CFP. 2352 by 1568 pixels — 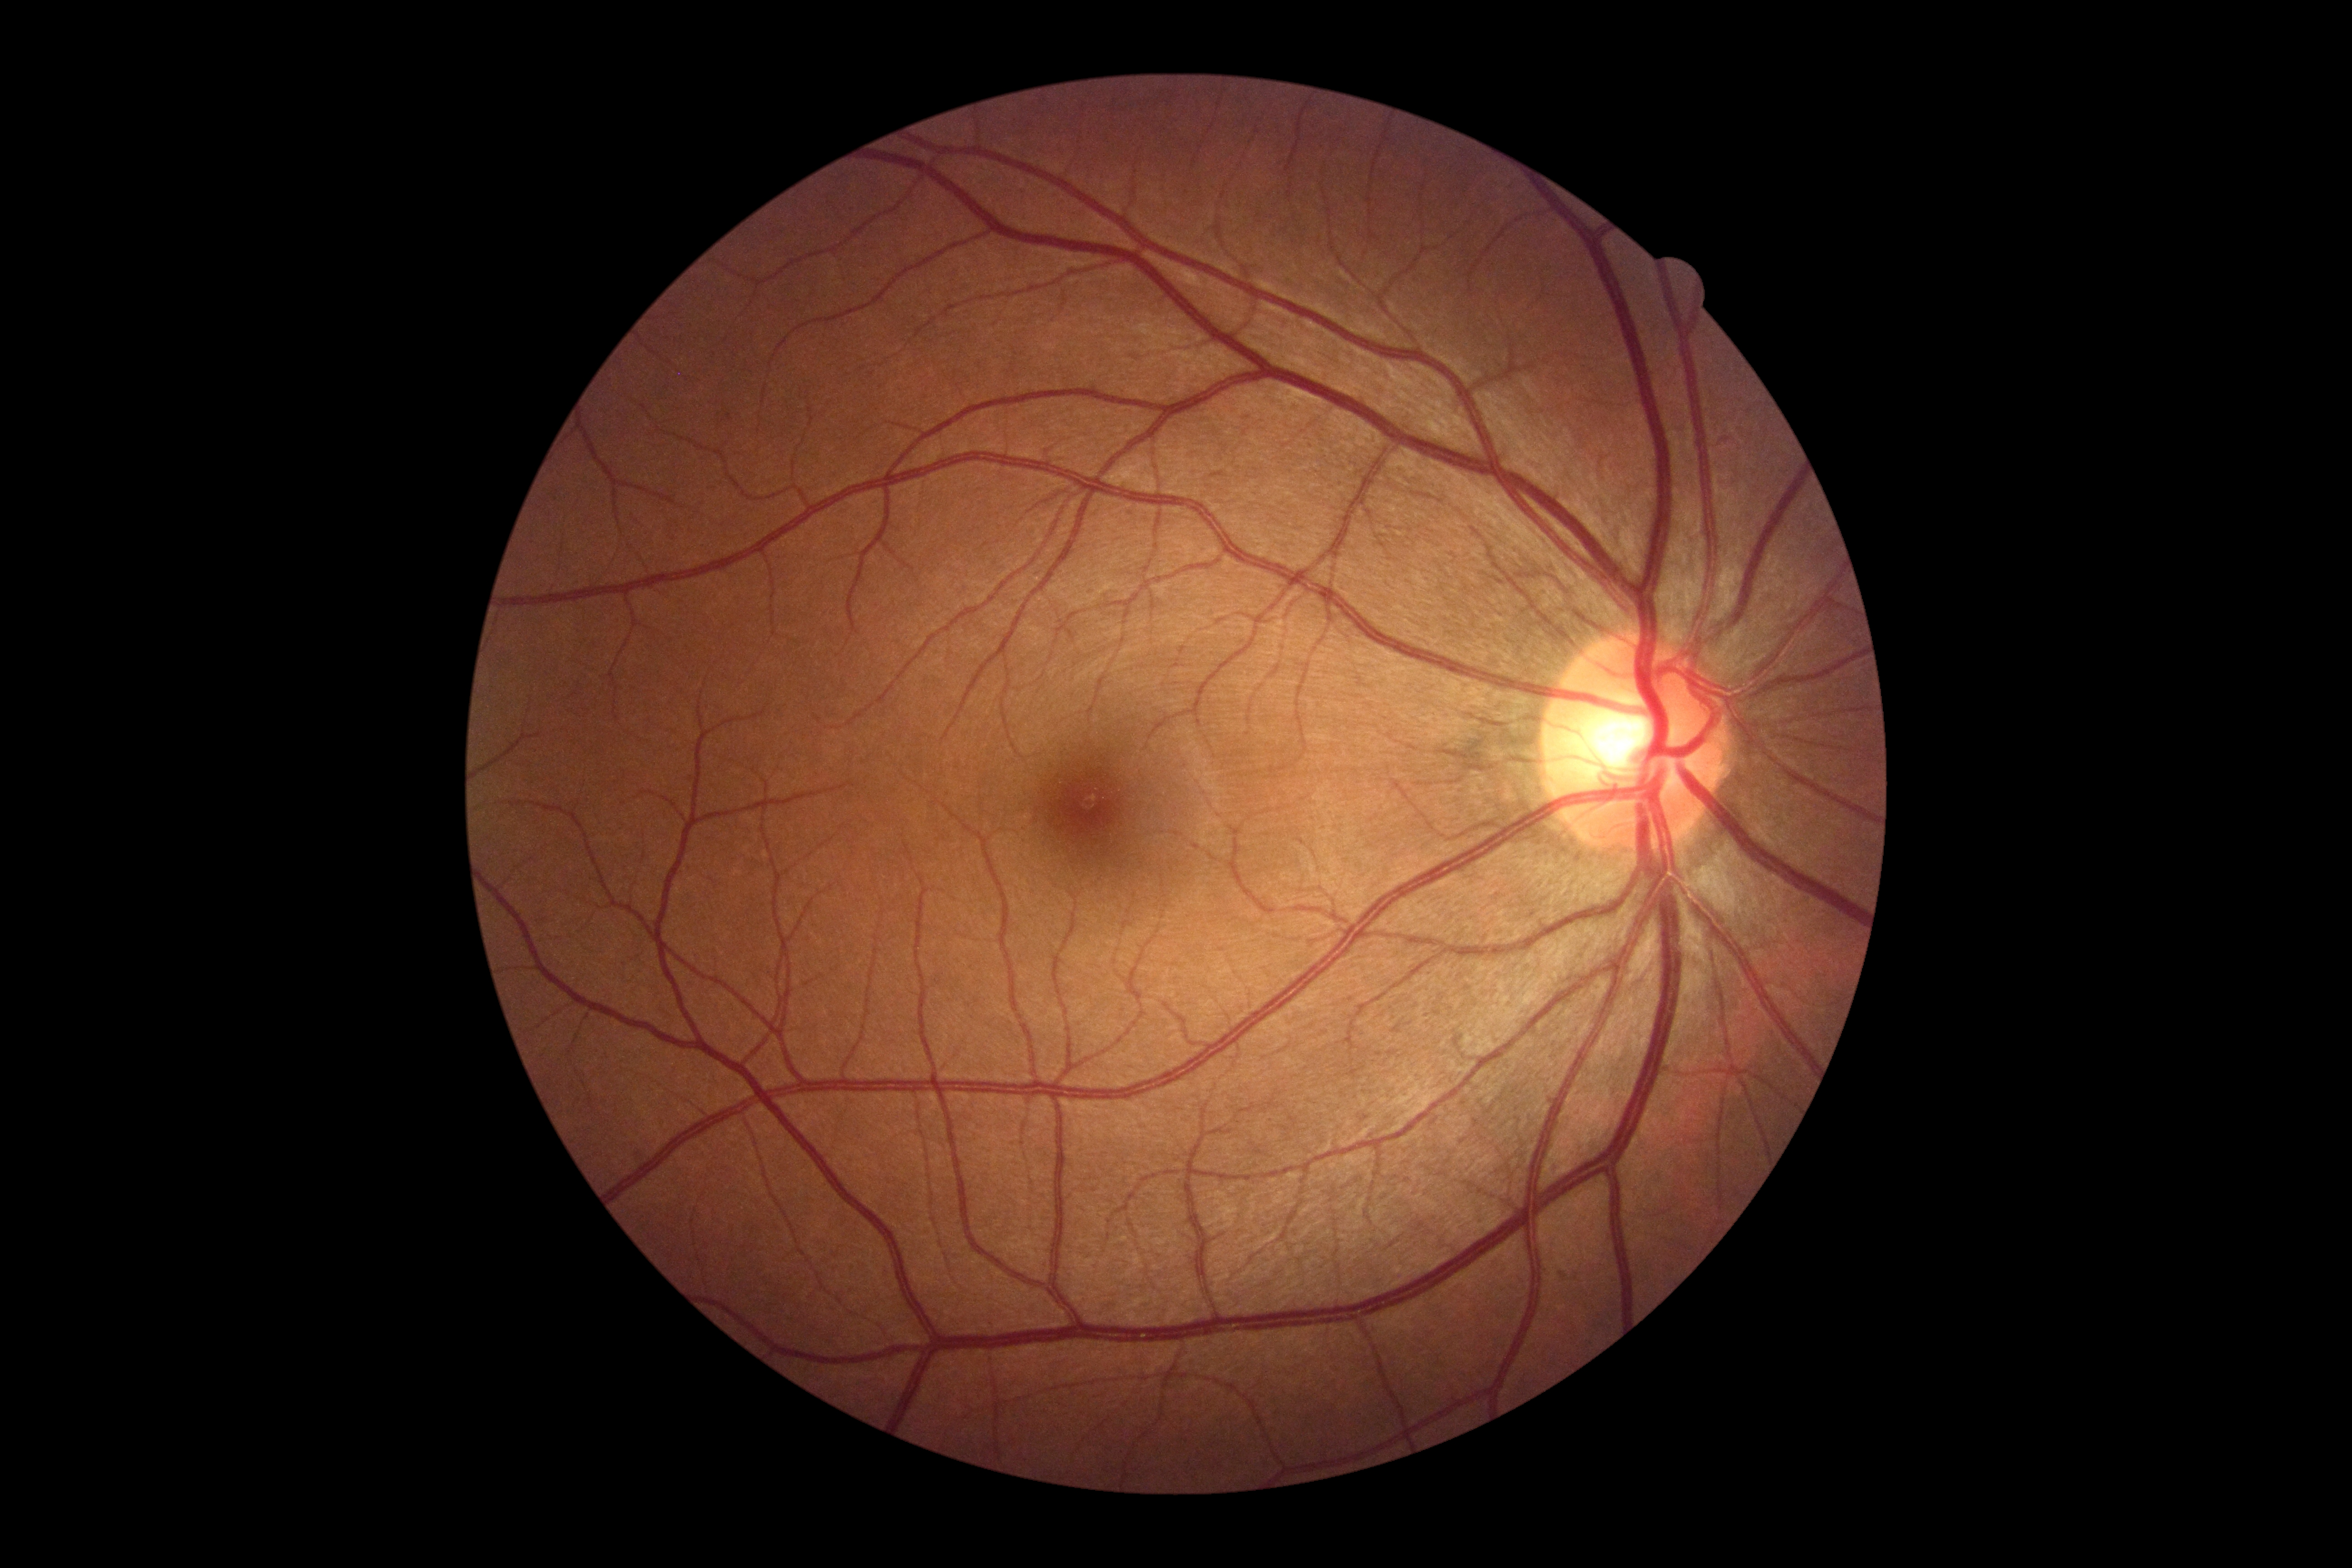

DR impression: no apparent DR; DR: grade 0 (no apparent retinopathy) — no visible signs of diabetic retinopathy.